Wide-field fundus photograph from neonatal ROP screening · 640 by 480 pixels.
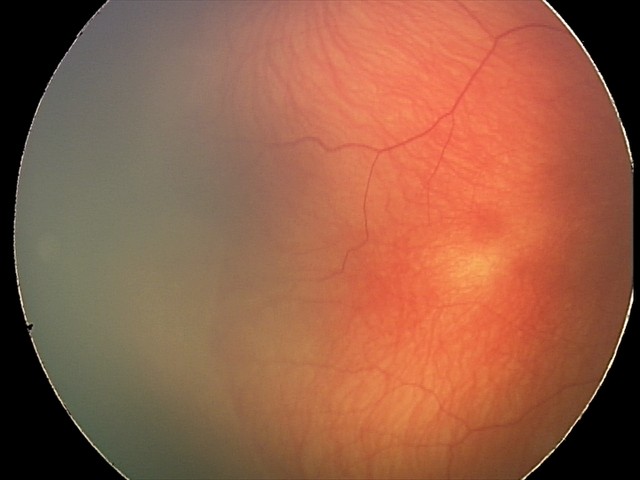

No plus disease. From an examination with diagnosis of ROP stage 2.